Acquired with a NIDEK AFC-230:
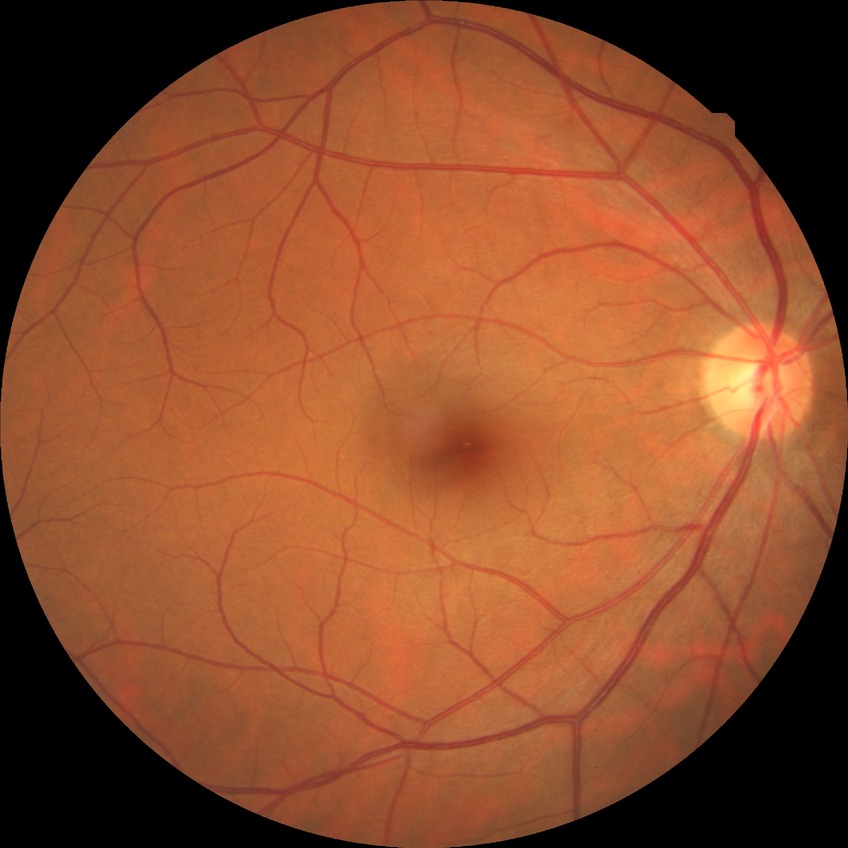 Diabetic retinopathy (DR) is NDR (no diabetic retinopathy).